2228x1652px; CFP; 50° FOV; camera: Topcon TRC-50DX; captured after pupil dilation; posterior pole view: 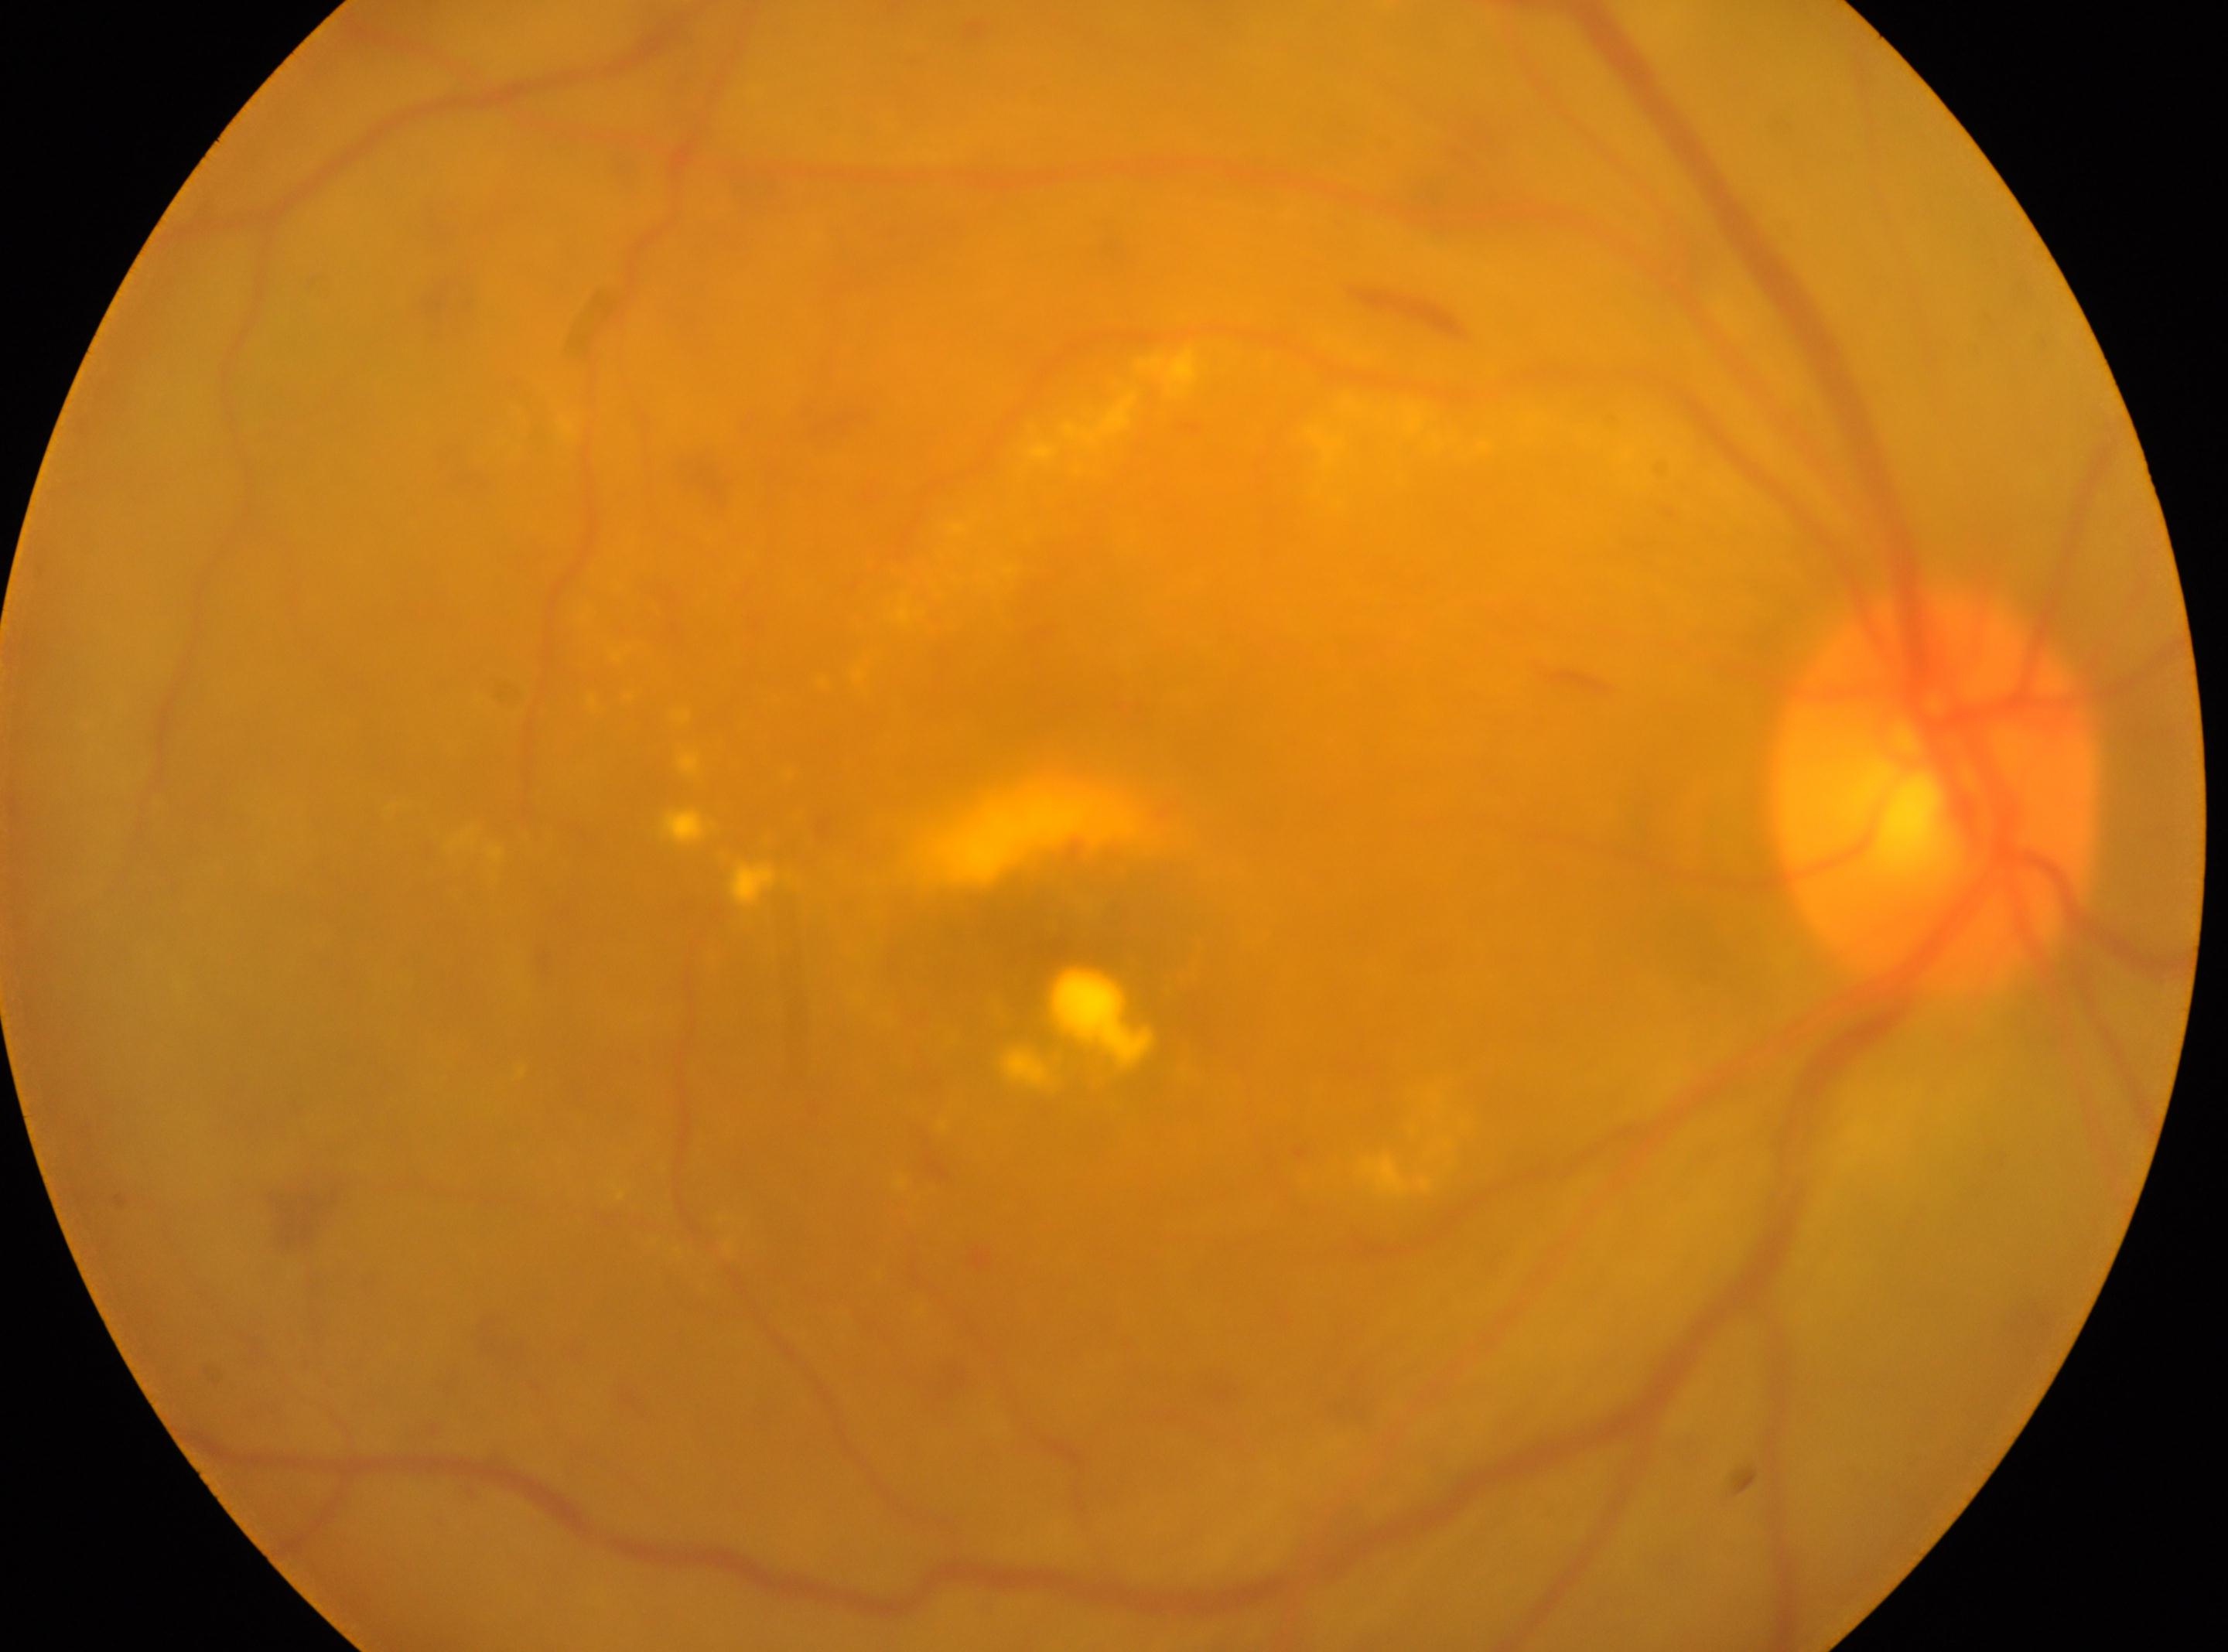 DR class: non-proliferative diabetic retinopathy.
Macular center: [1049, 936].
The optic disk is at [1936, 792].
DR severity is grade 2.
The image shows the oculus dexter.